Davis DR grading
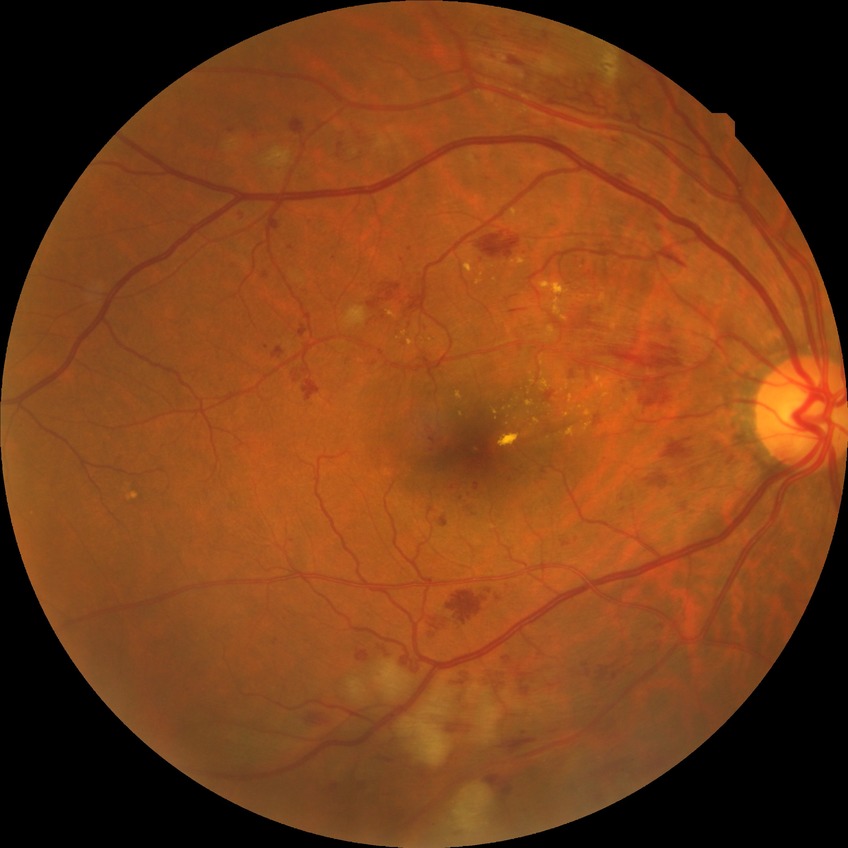
diabetic retinopathy grade=pre-proliferative diabetic retinopathy.